Image size 2352x1568: 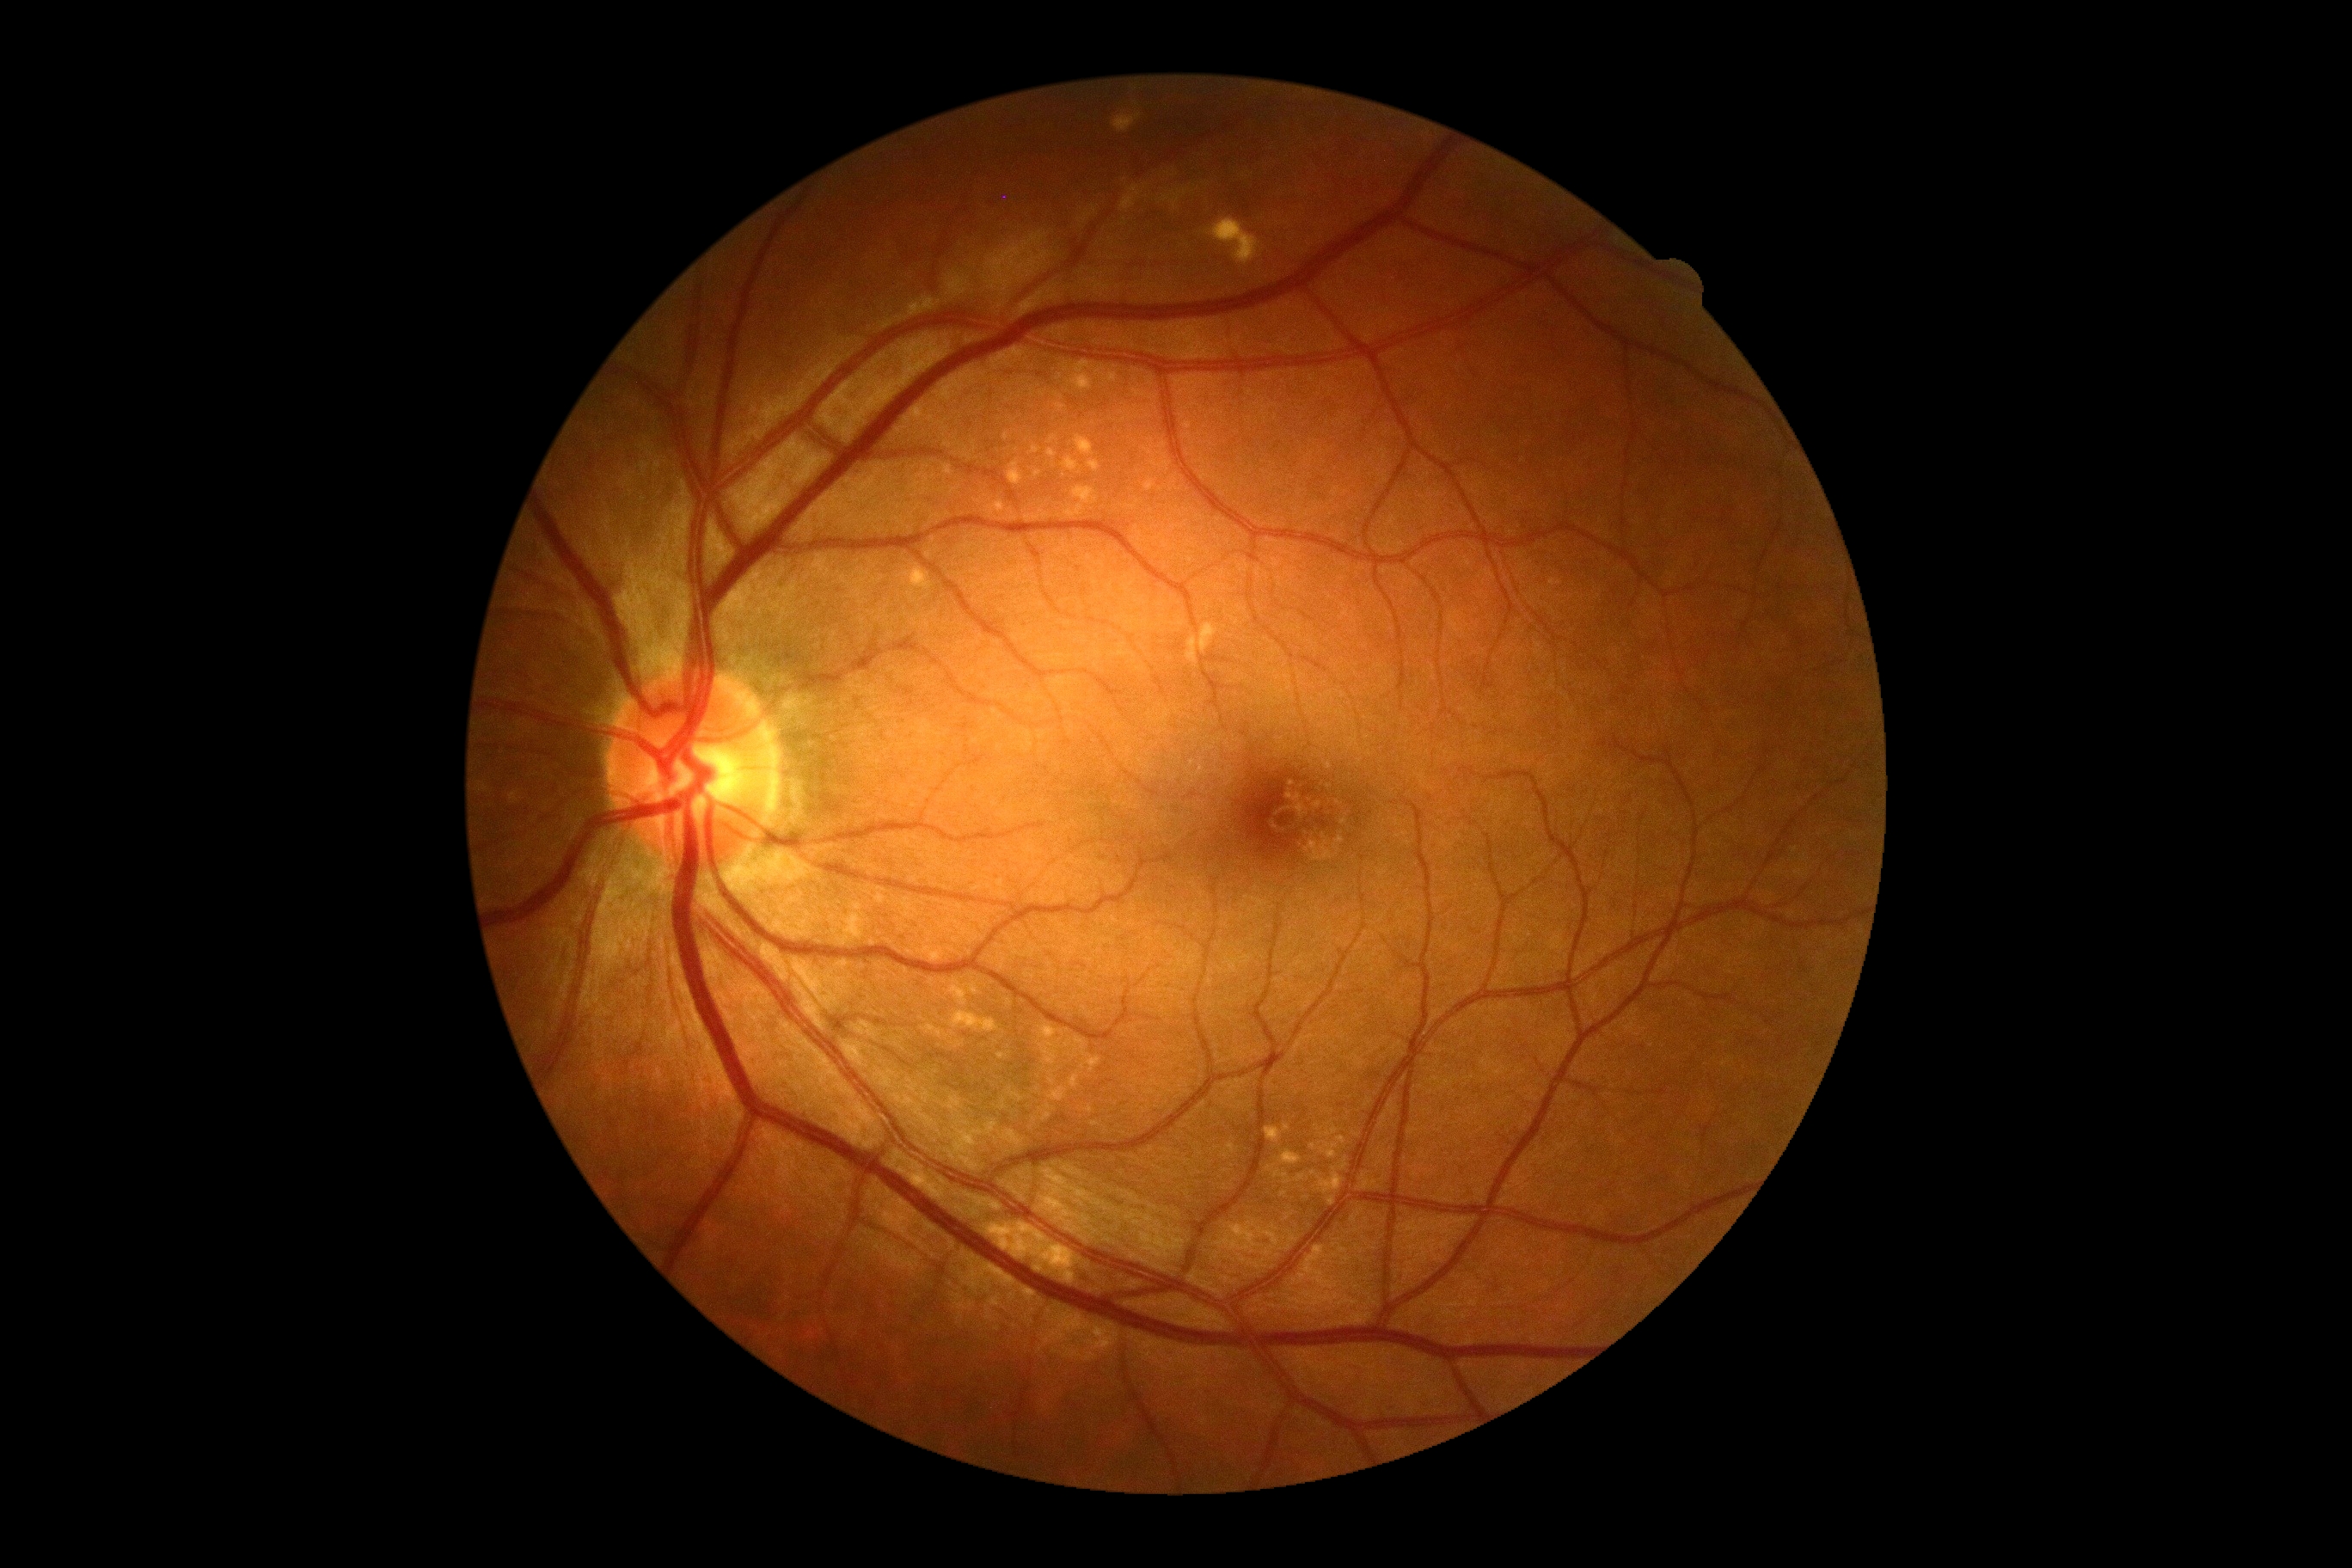
DR impression@no apparent DR; diabetic retinopathy (DR)@no apparent diabetic retinopathy (grade 0).